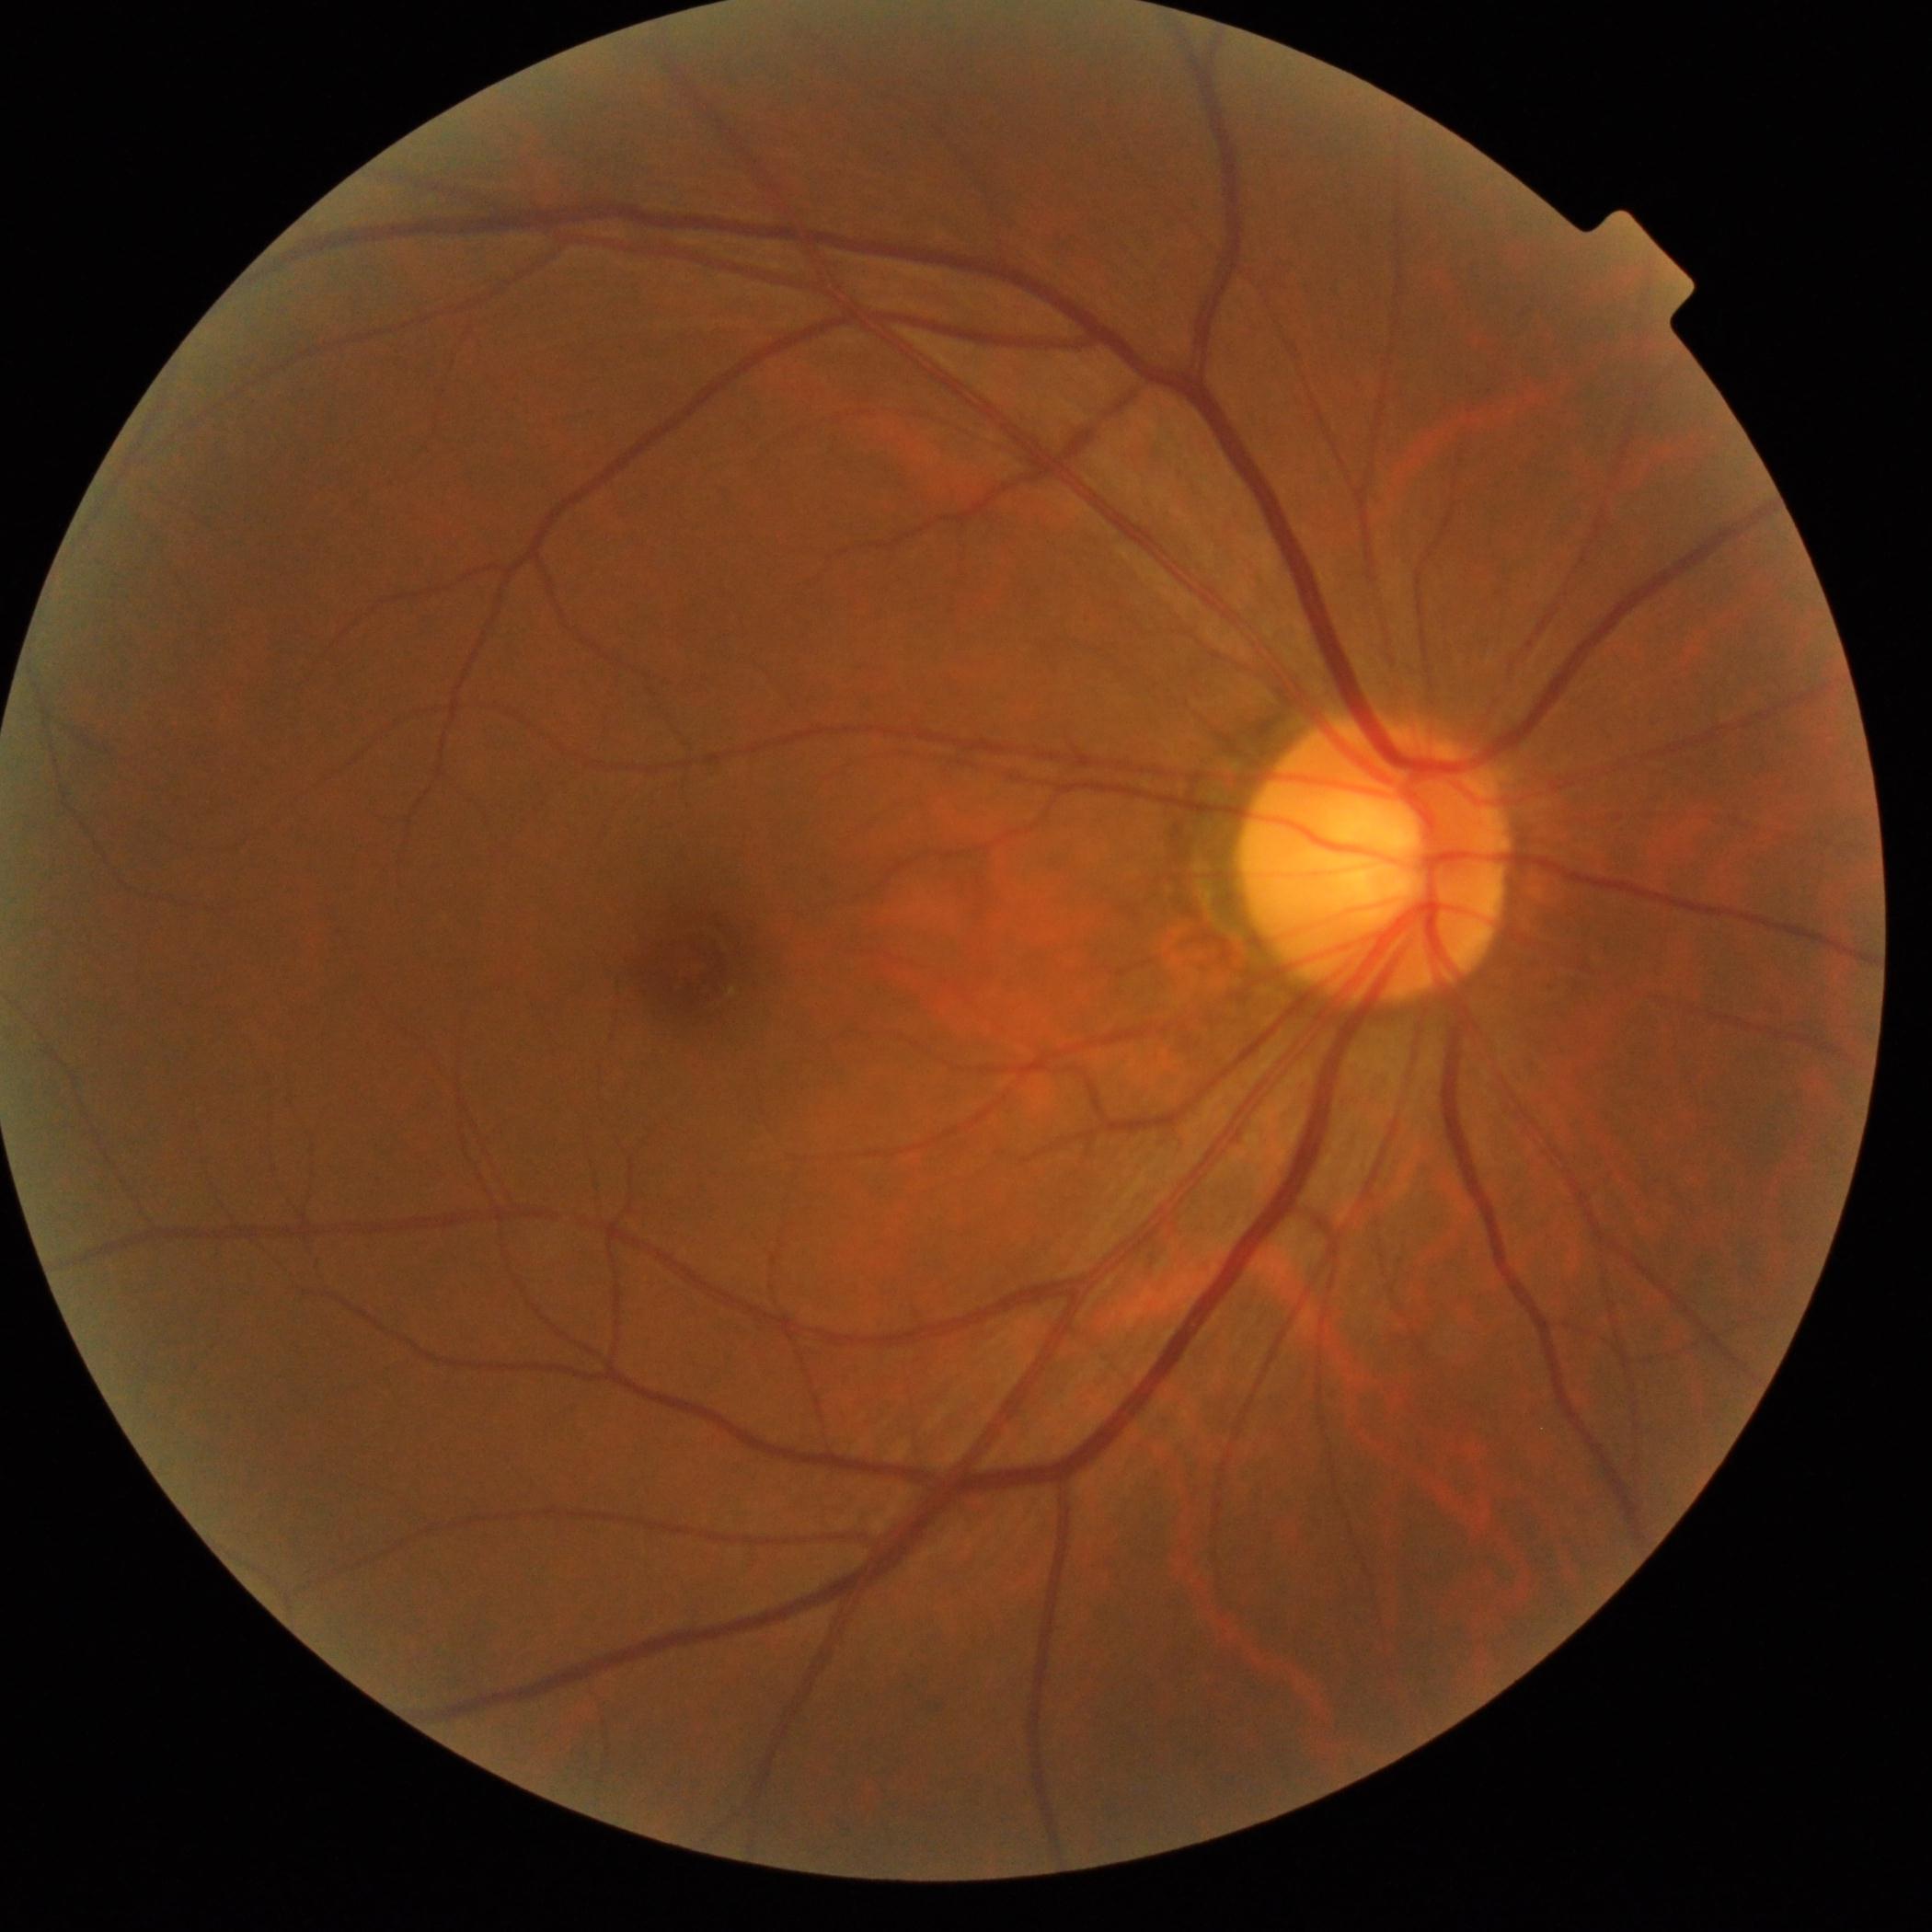
Findings:
• diabetic retinopathy (DR) — 0 — no visible signs of diabetic retinopathy